Topcon TRC-NW8, FOV: 50 degrees, CFP: 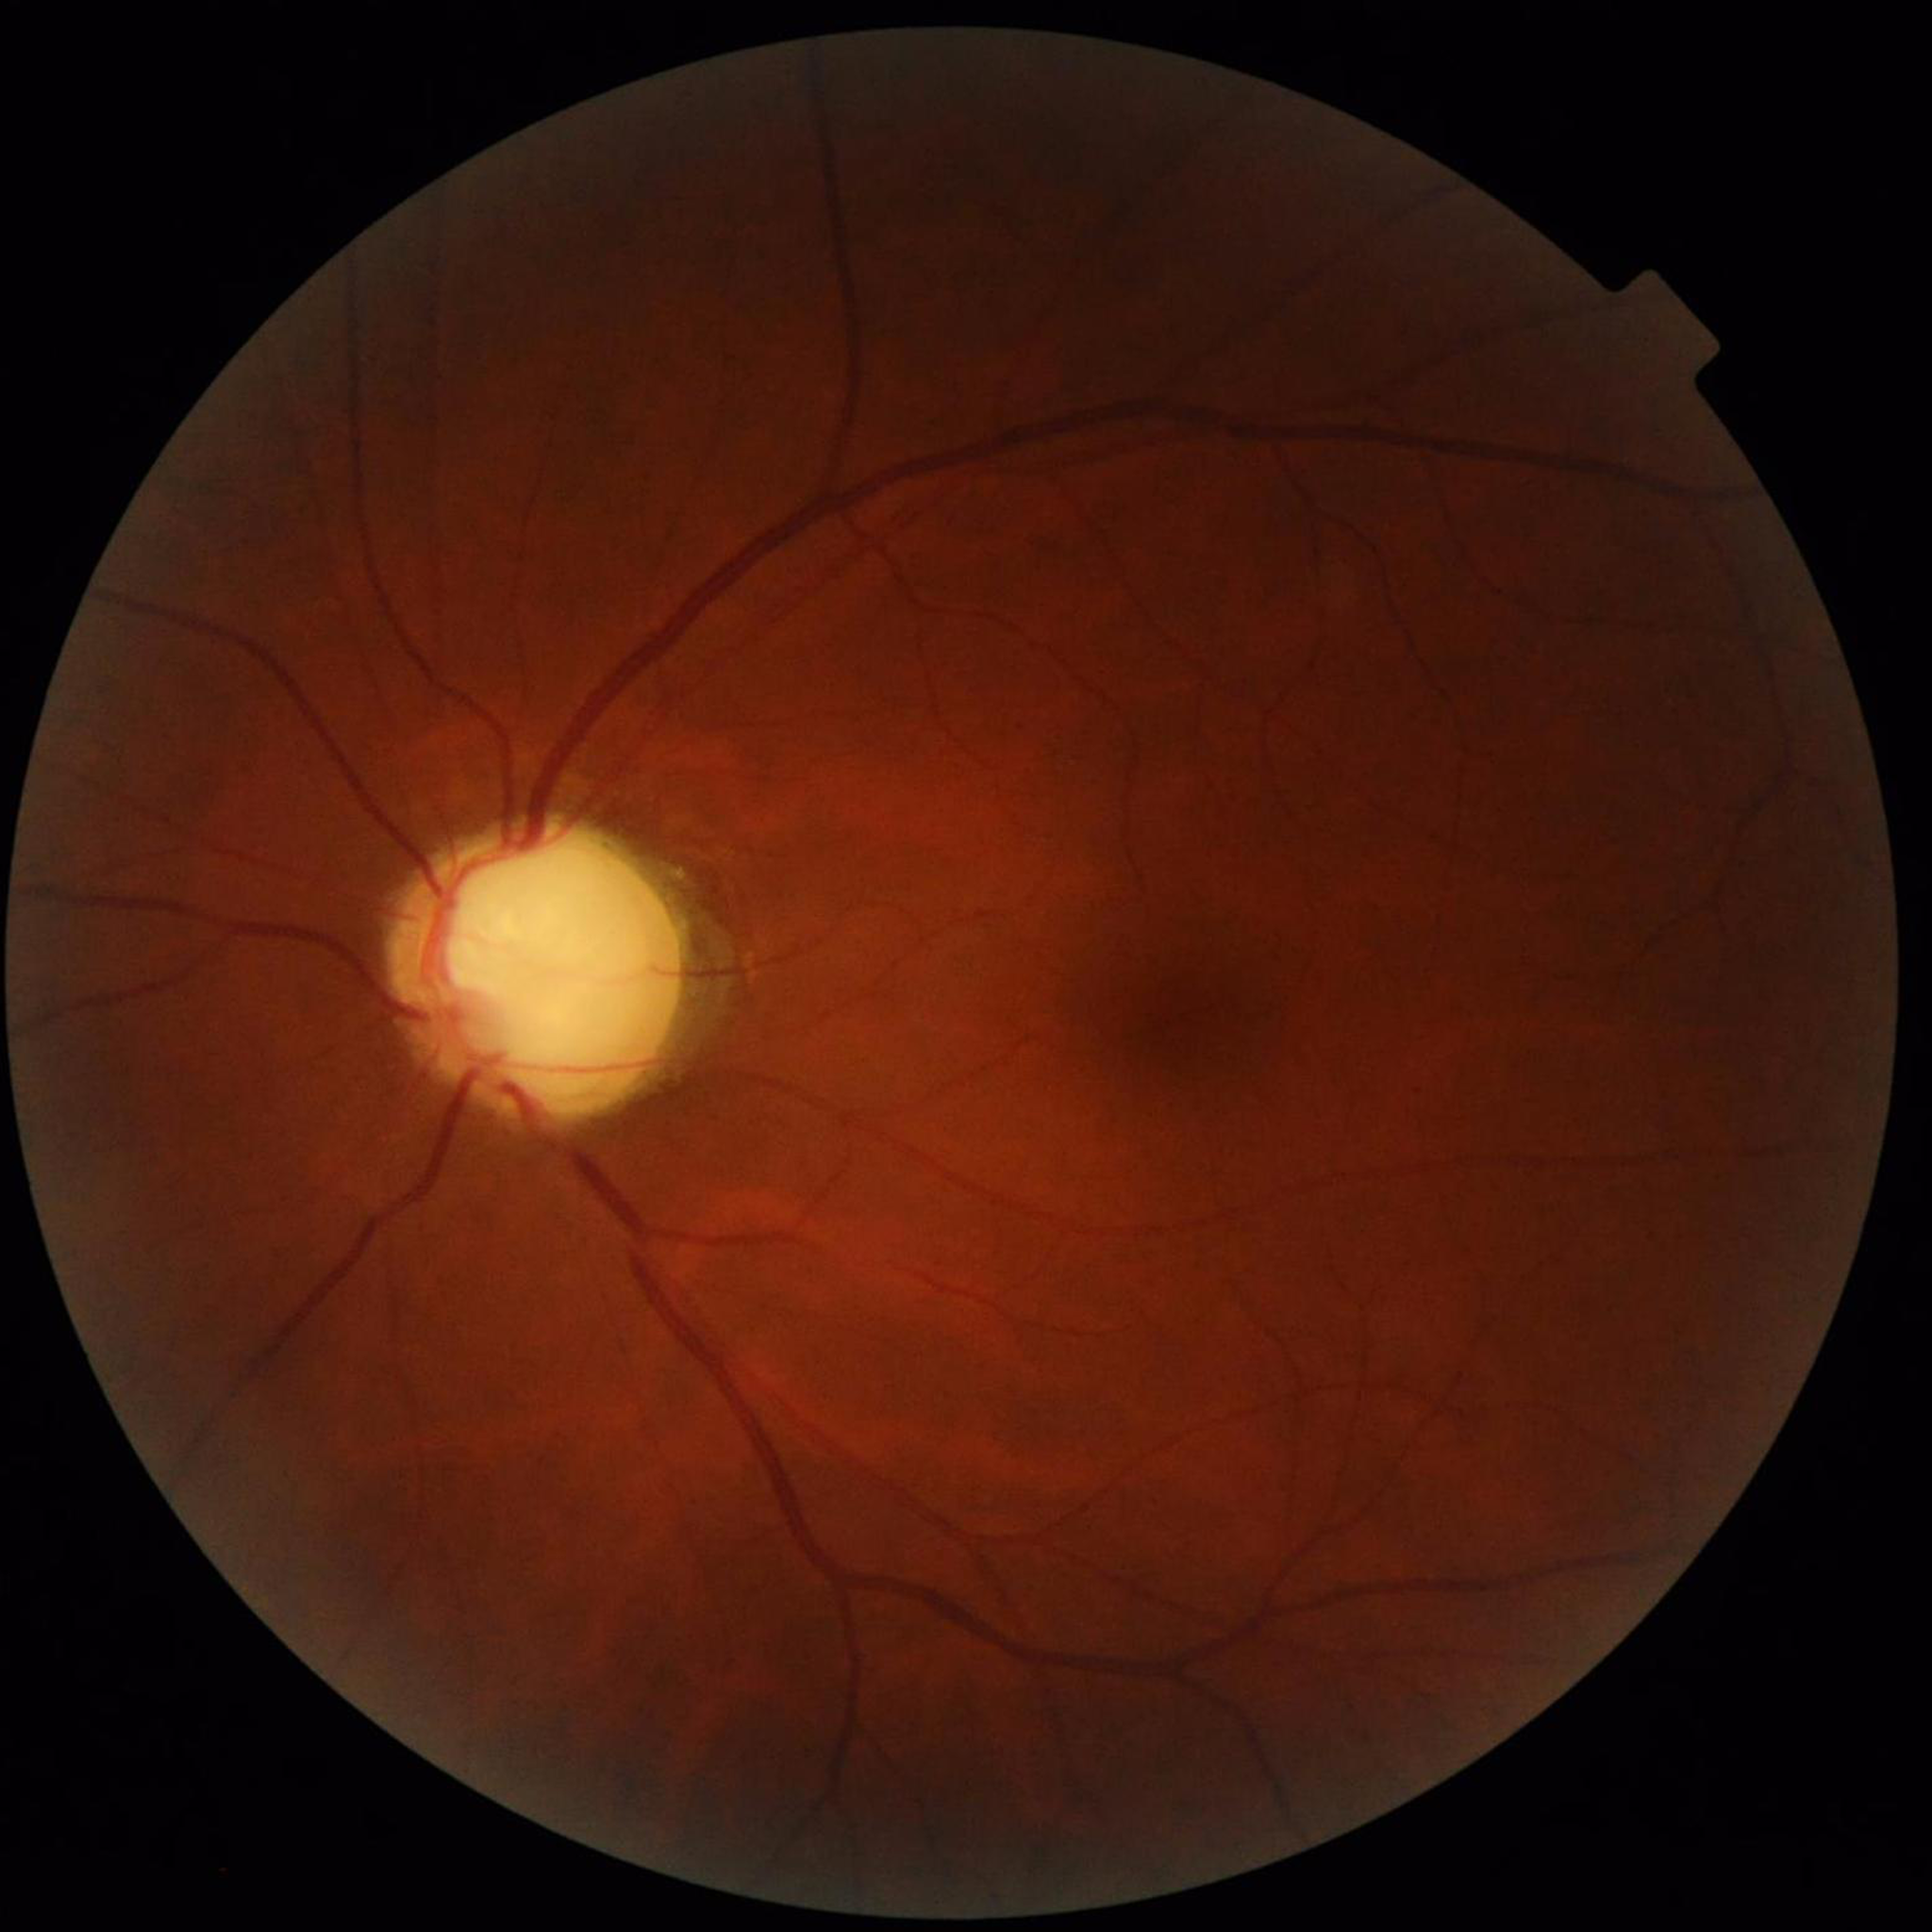 Quality: suboptimal — illumination/color distortion.
Diagnosed with glaucoma.